FOV: 45 degrees; 2212x1672px; color fundus photograph
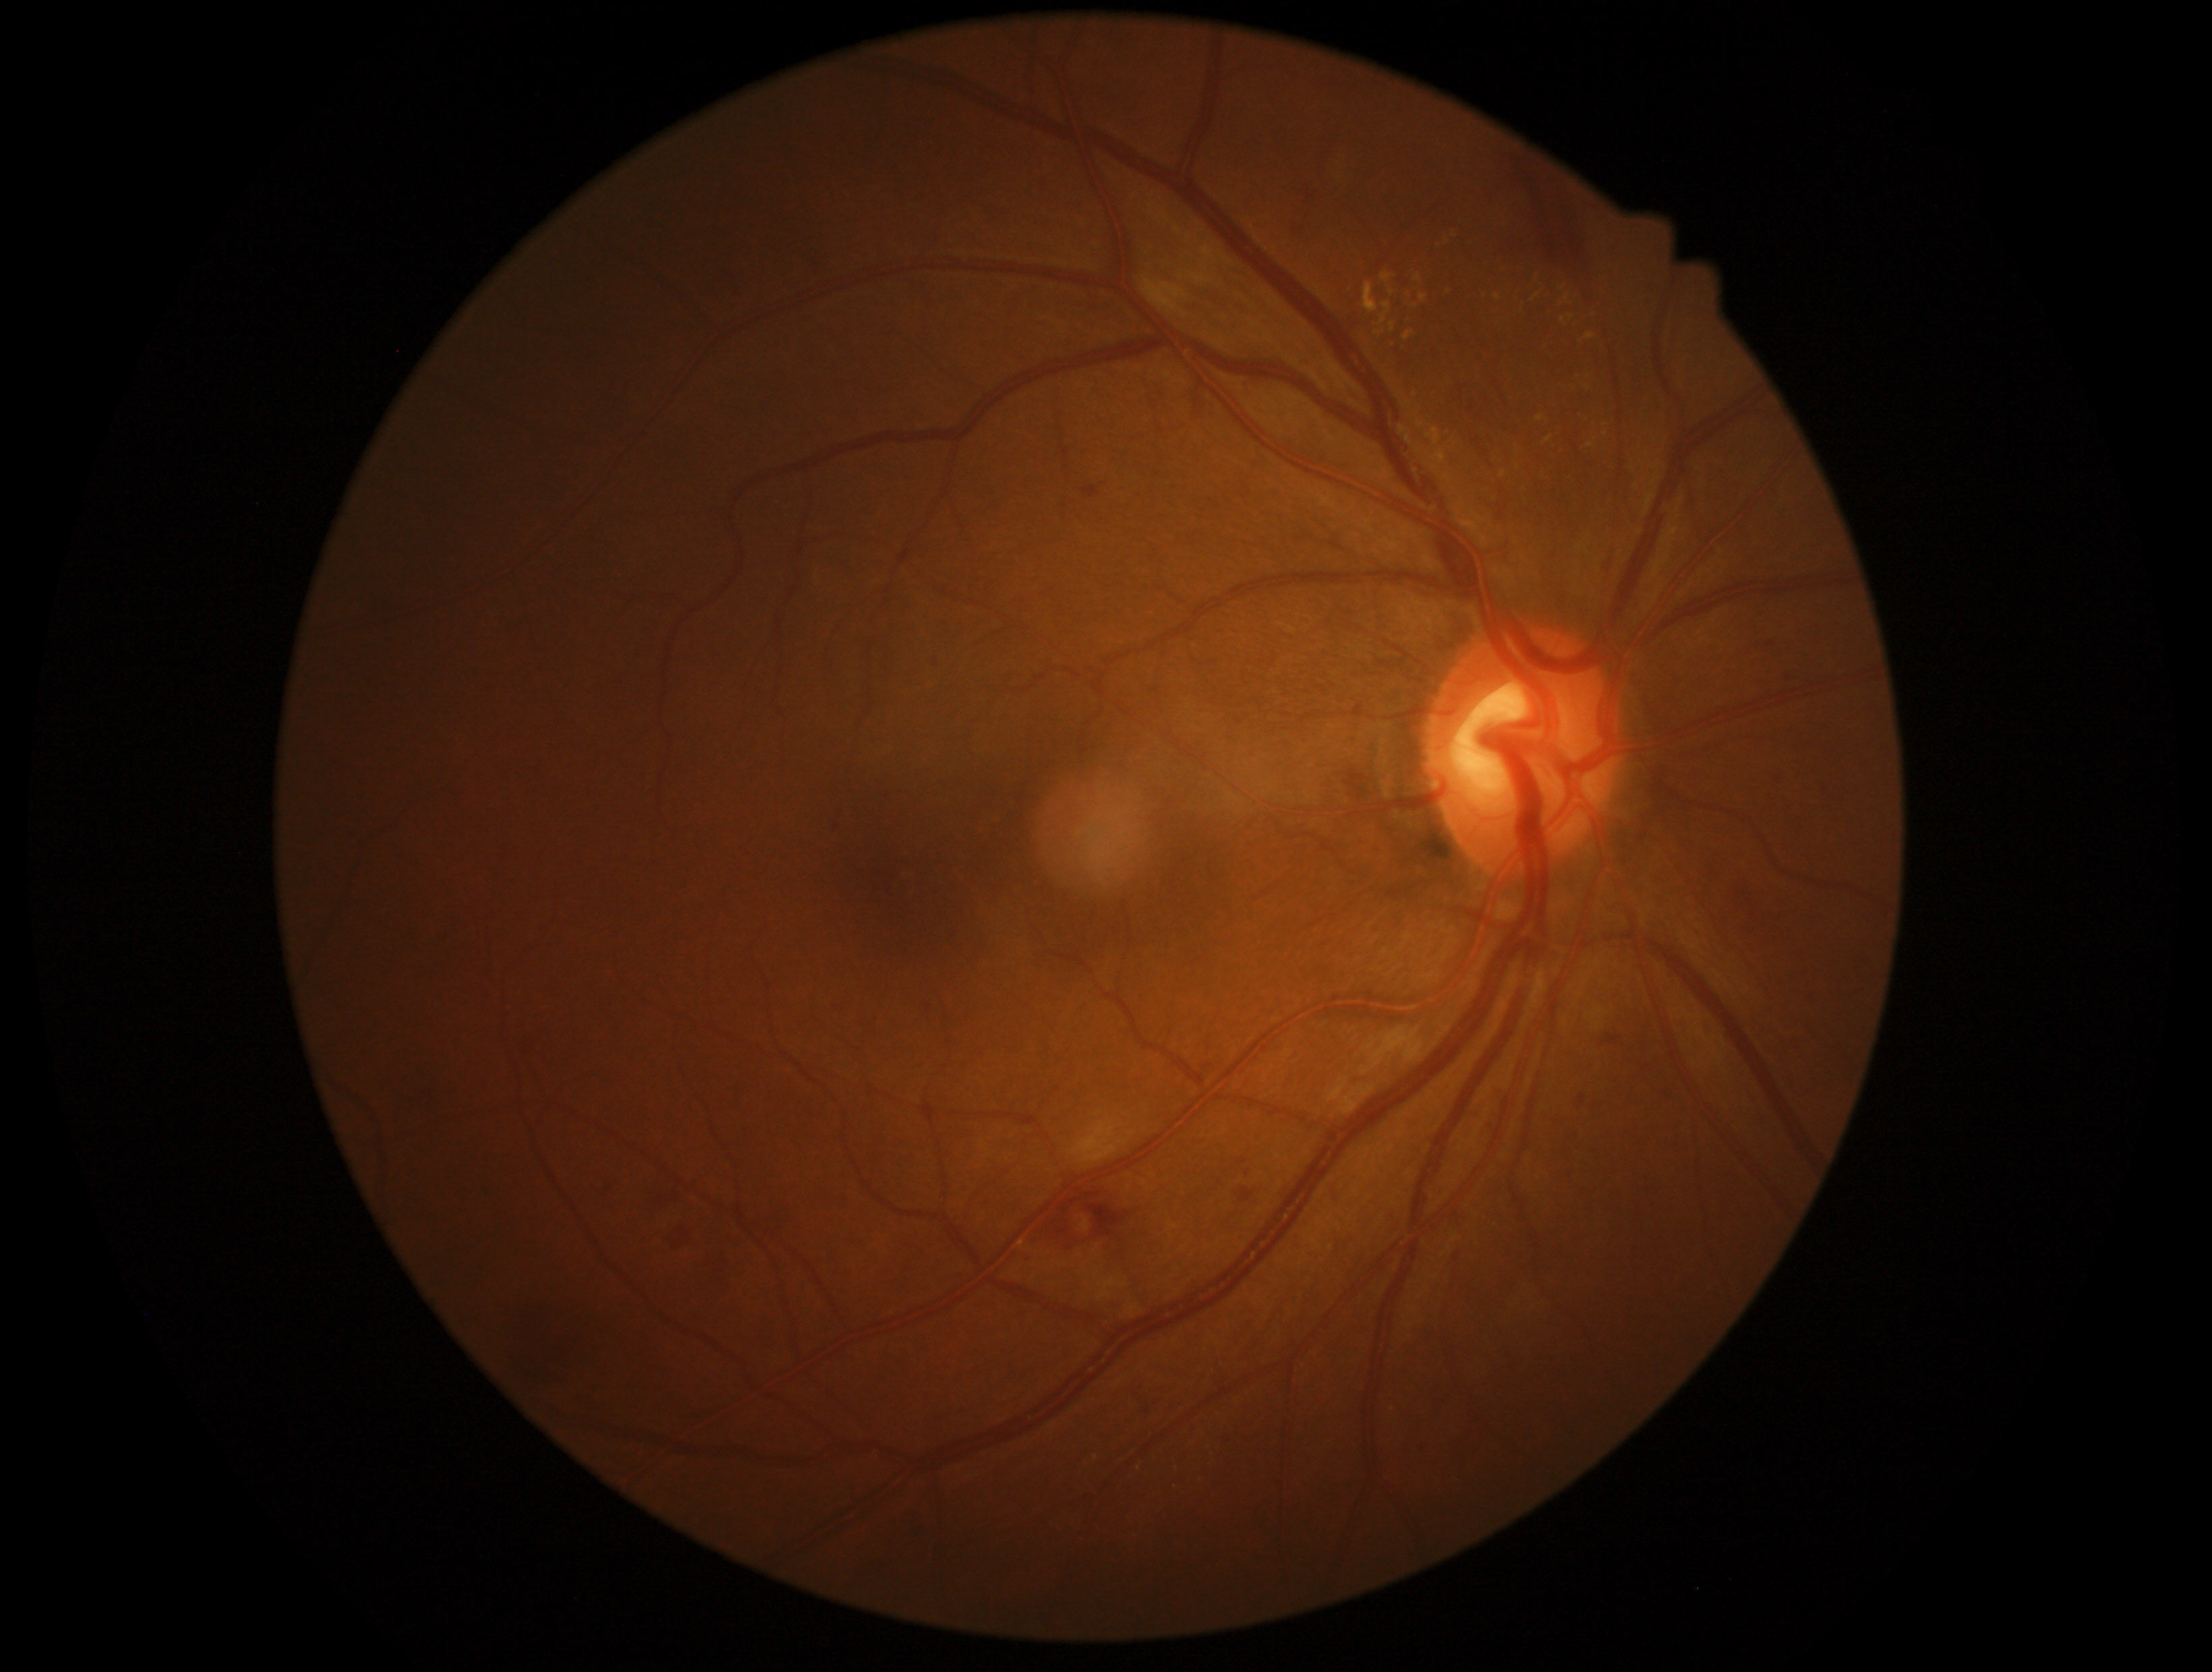

Diabetic retinopathy (DR) is grade 2 — more than just microaneurysms but less than severe NPDR.